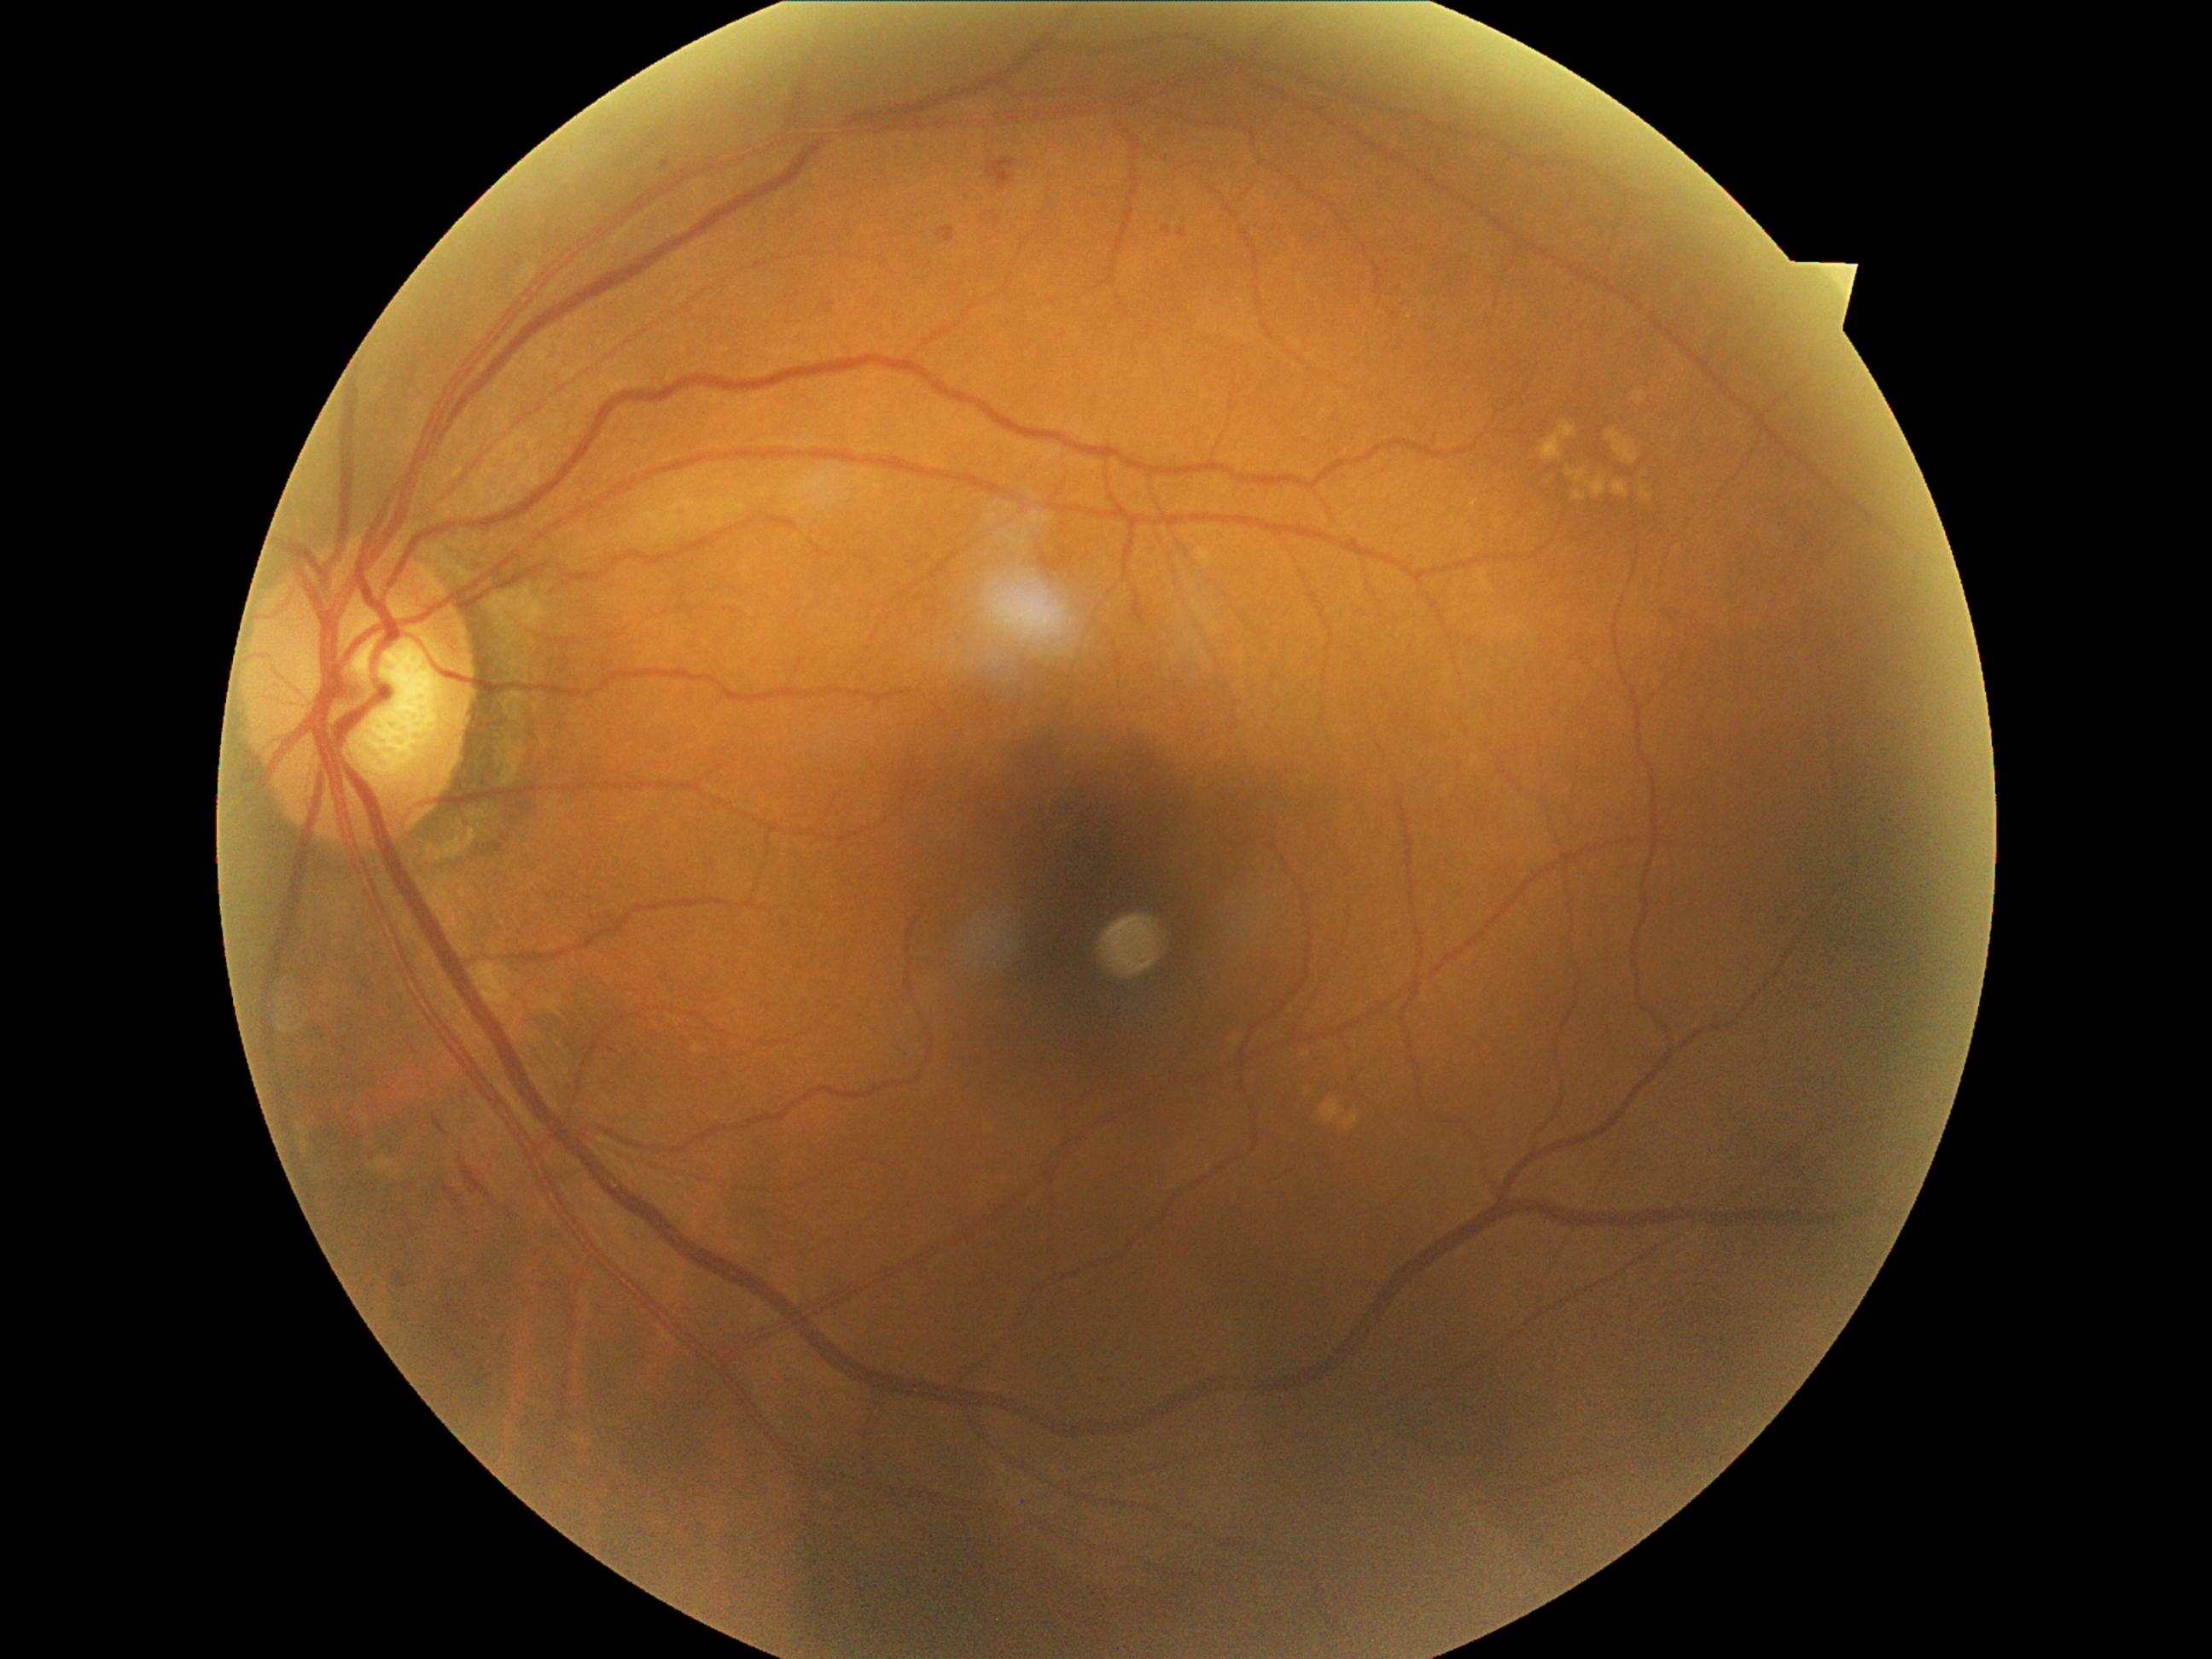

DR stage: 2/4.